Camera: Clarity RetCam 3 (130° FOV) · 640x480 · wide-field fundus image from infant ROP screening.
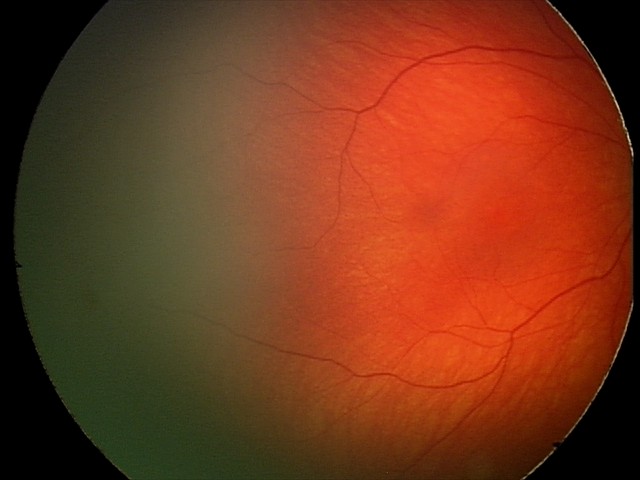
Examination with physiological retinal findings.